45° field of view. 2352x1568. Color fundus image:
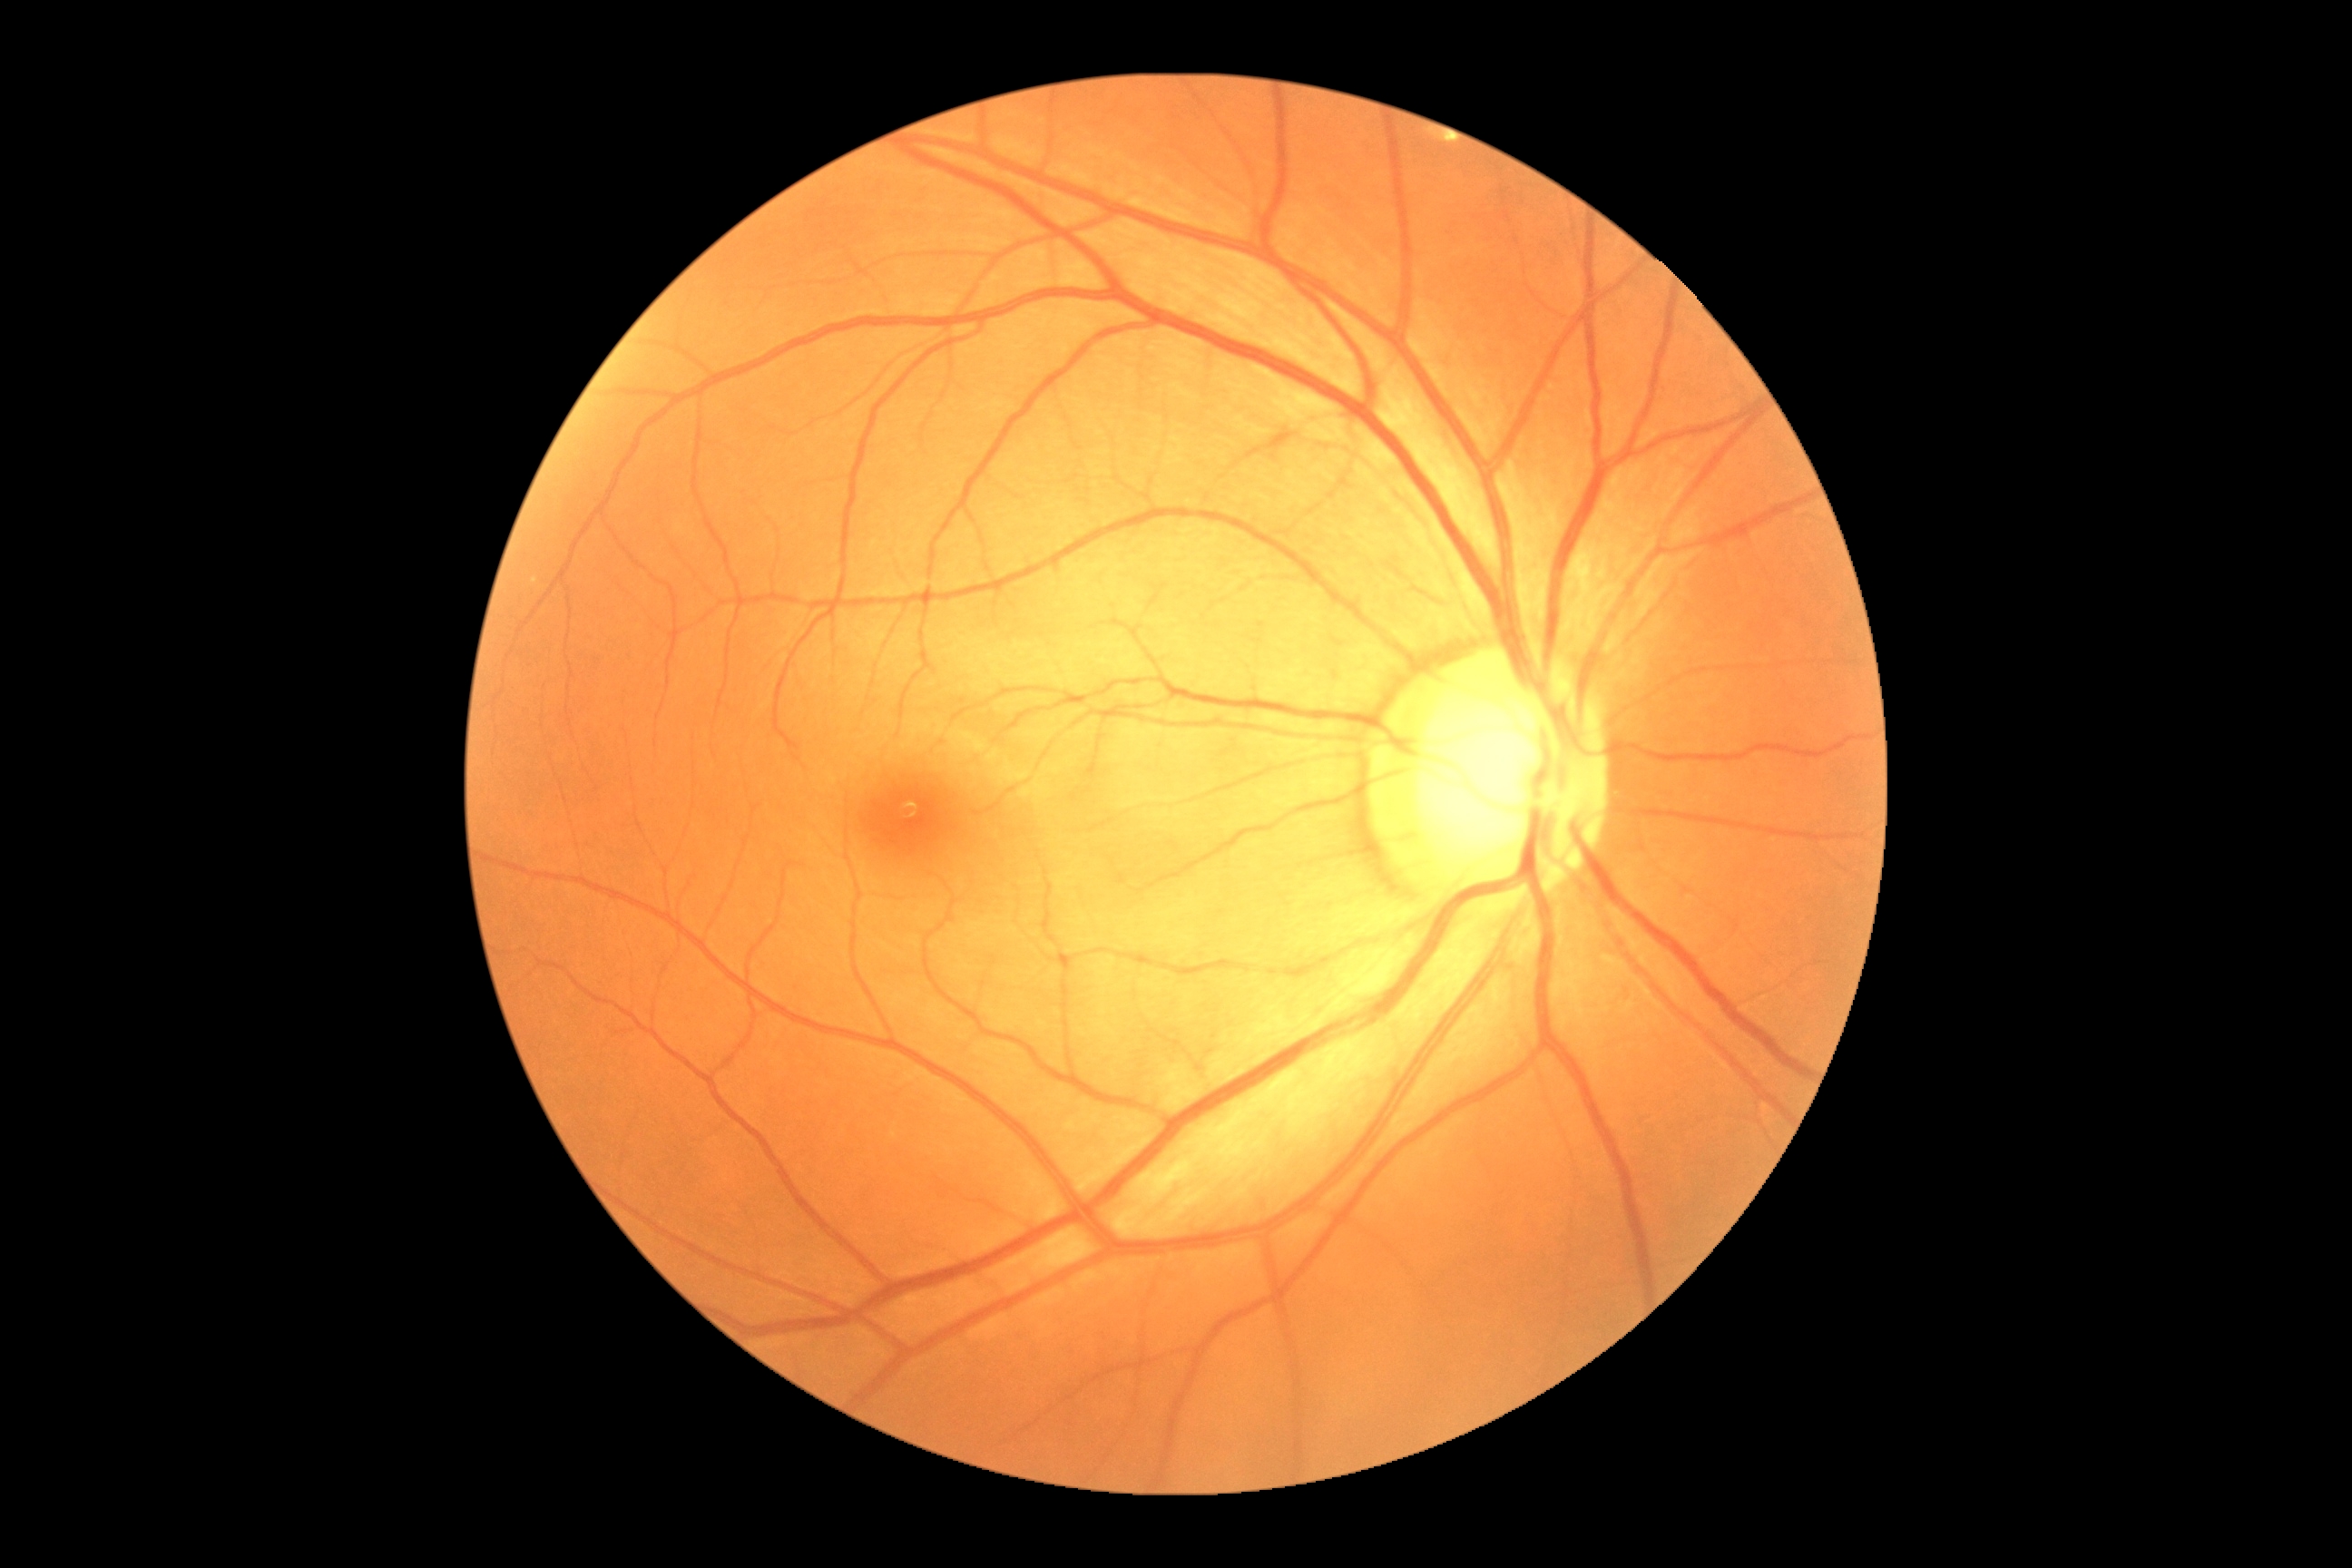 Diabetic retinopathy (DR) is grade 0 (no apparent retinopathy).